Color fundus photograph. 2184x1690px. 45-degree field of view: 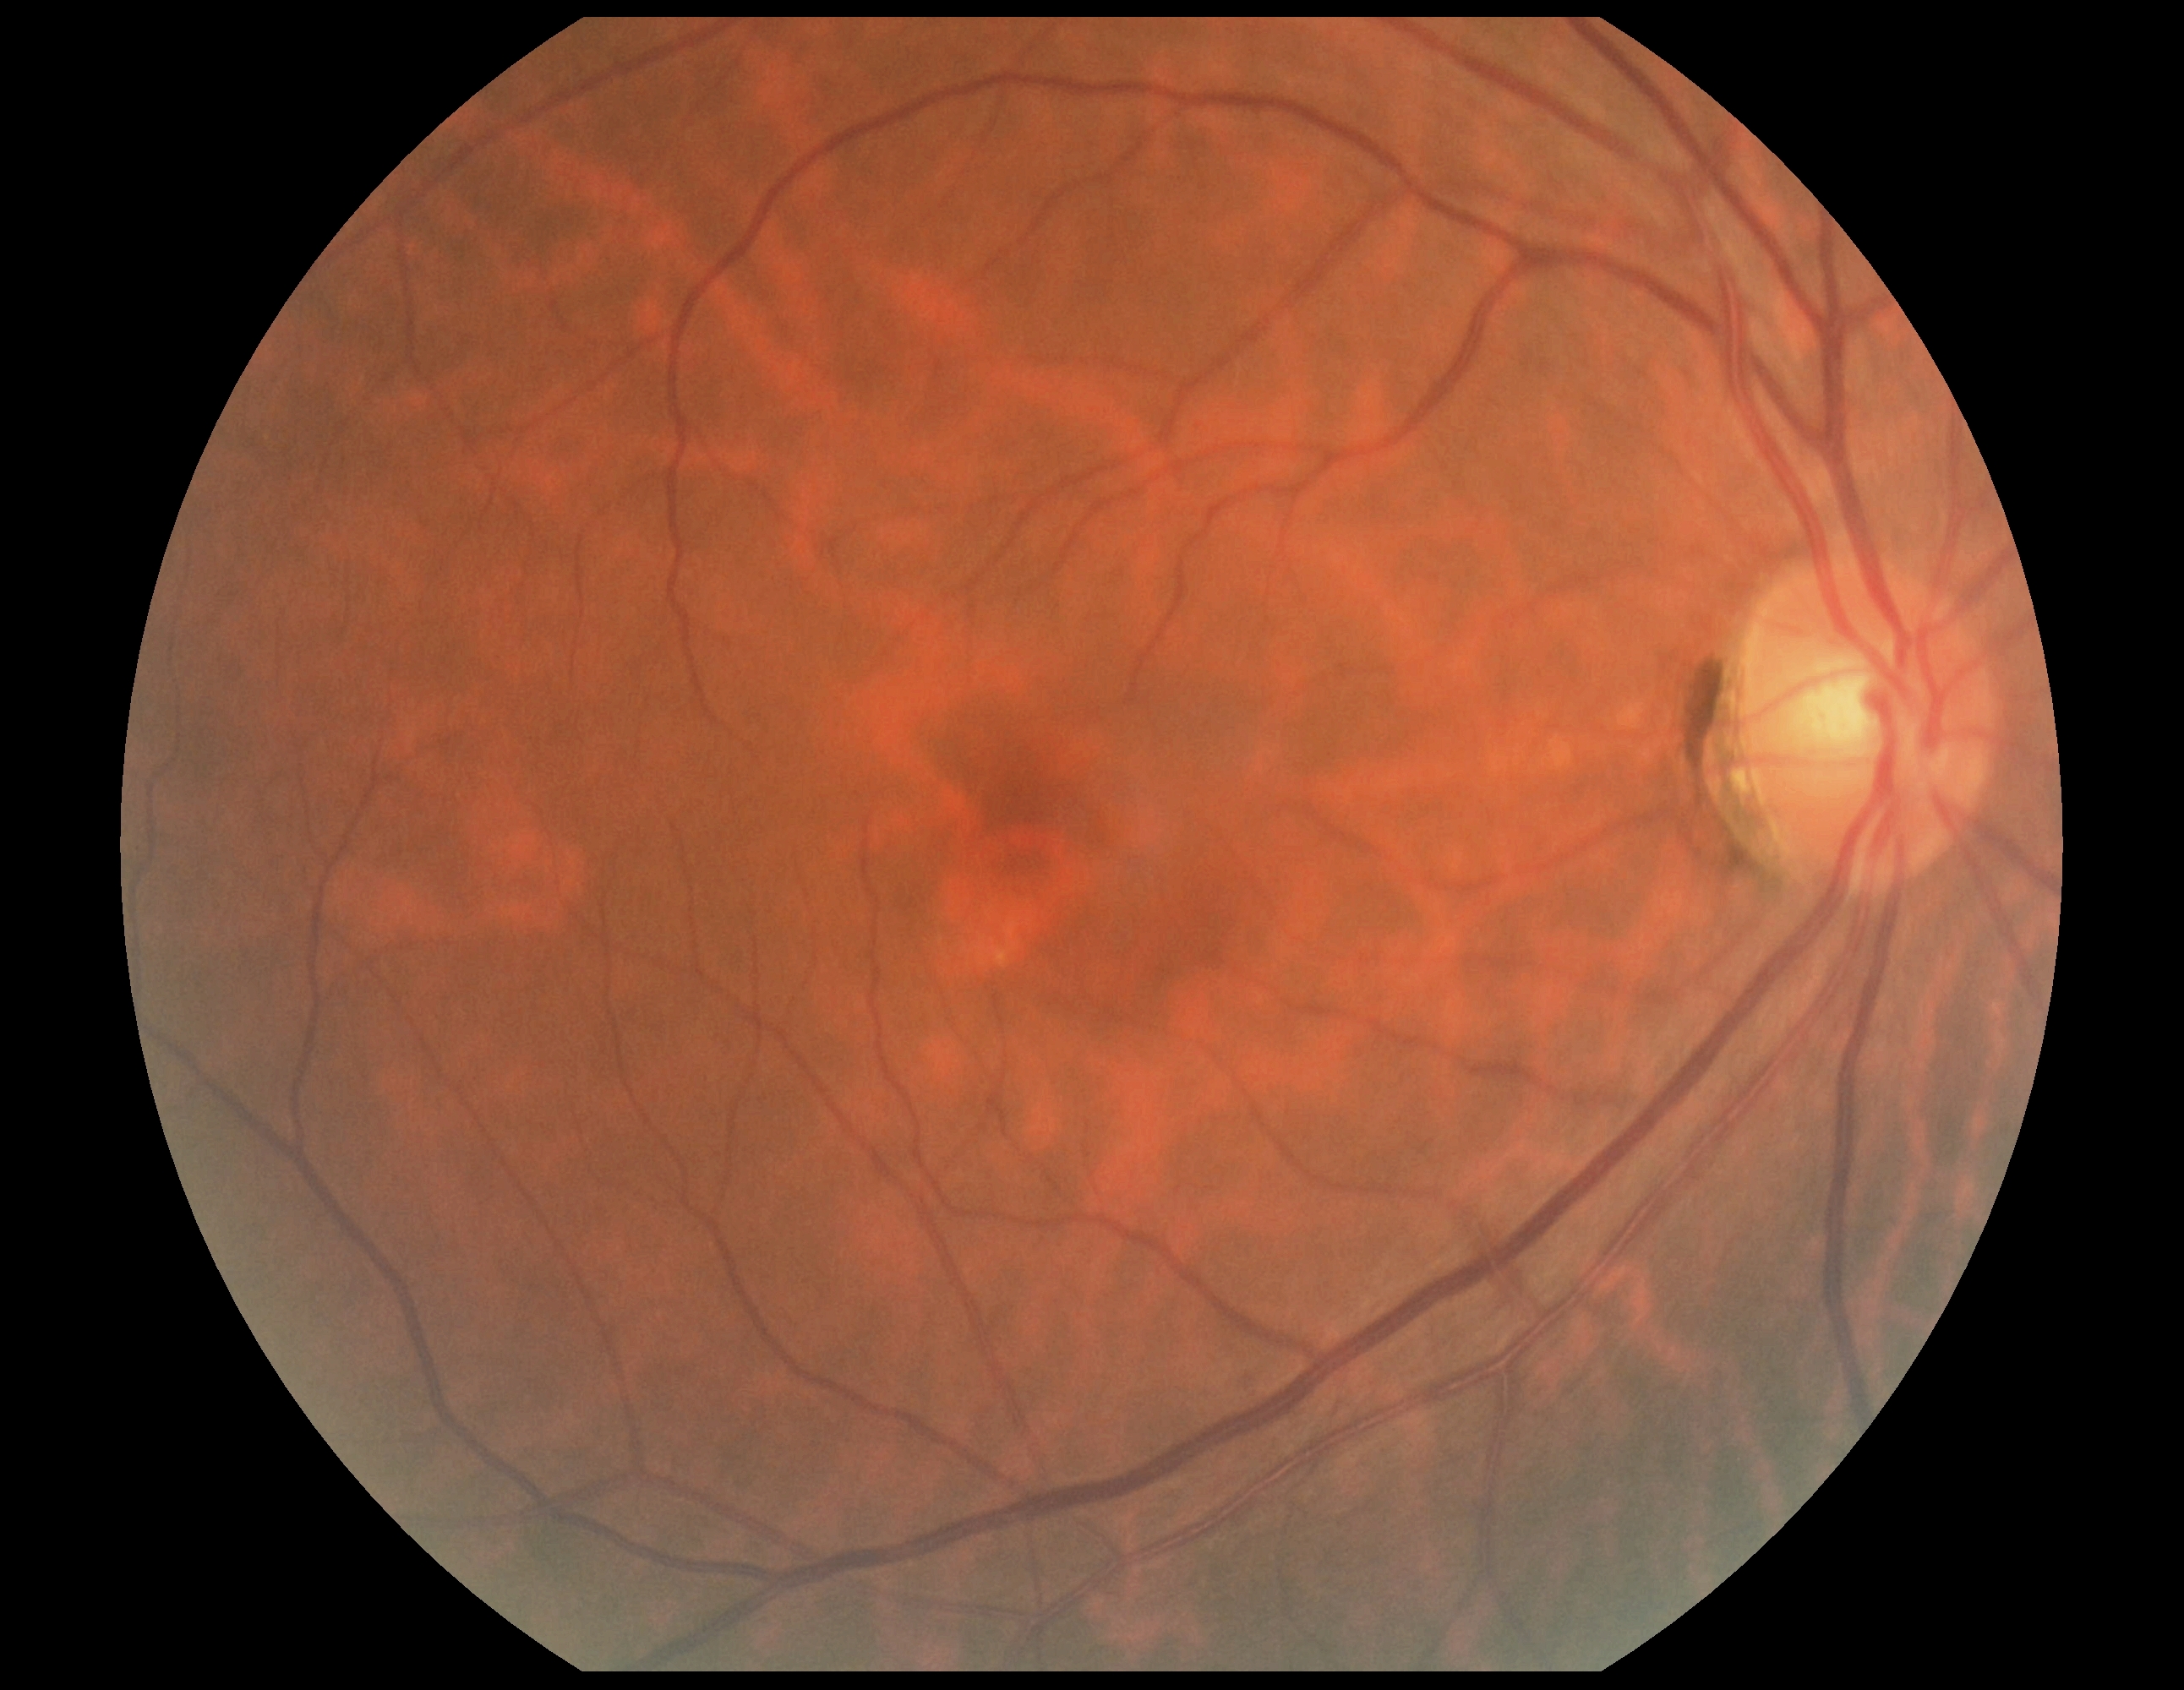 DR severity: grade 0 (no apparent retinopathy). No DR findings.